Fundus photo — 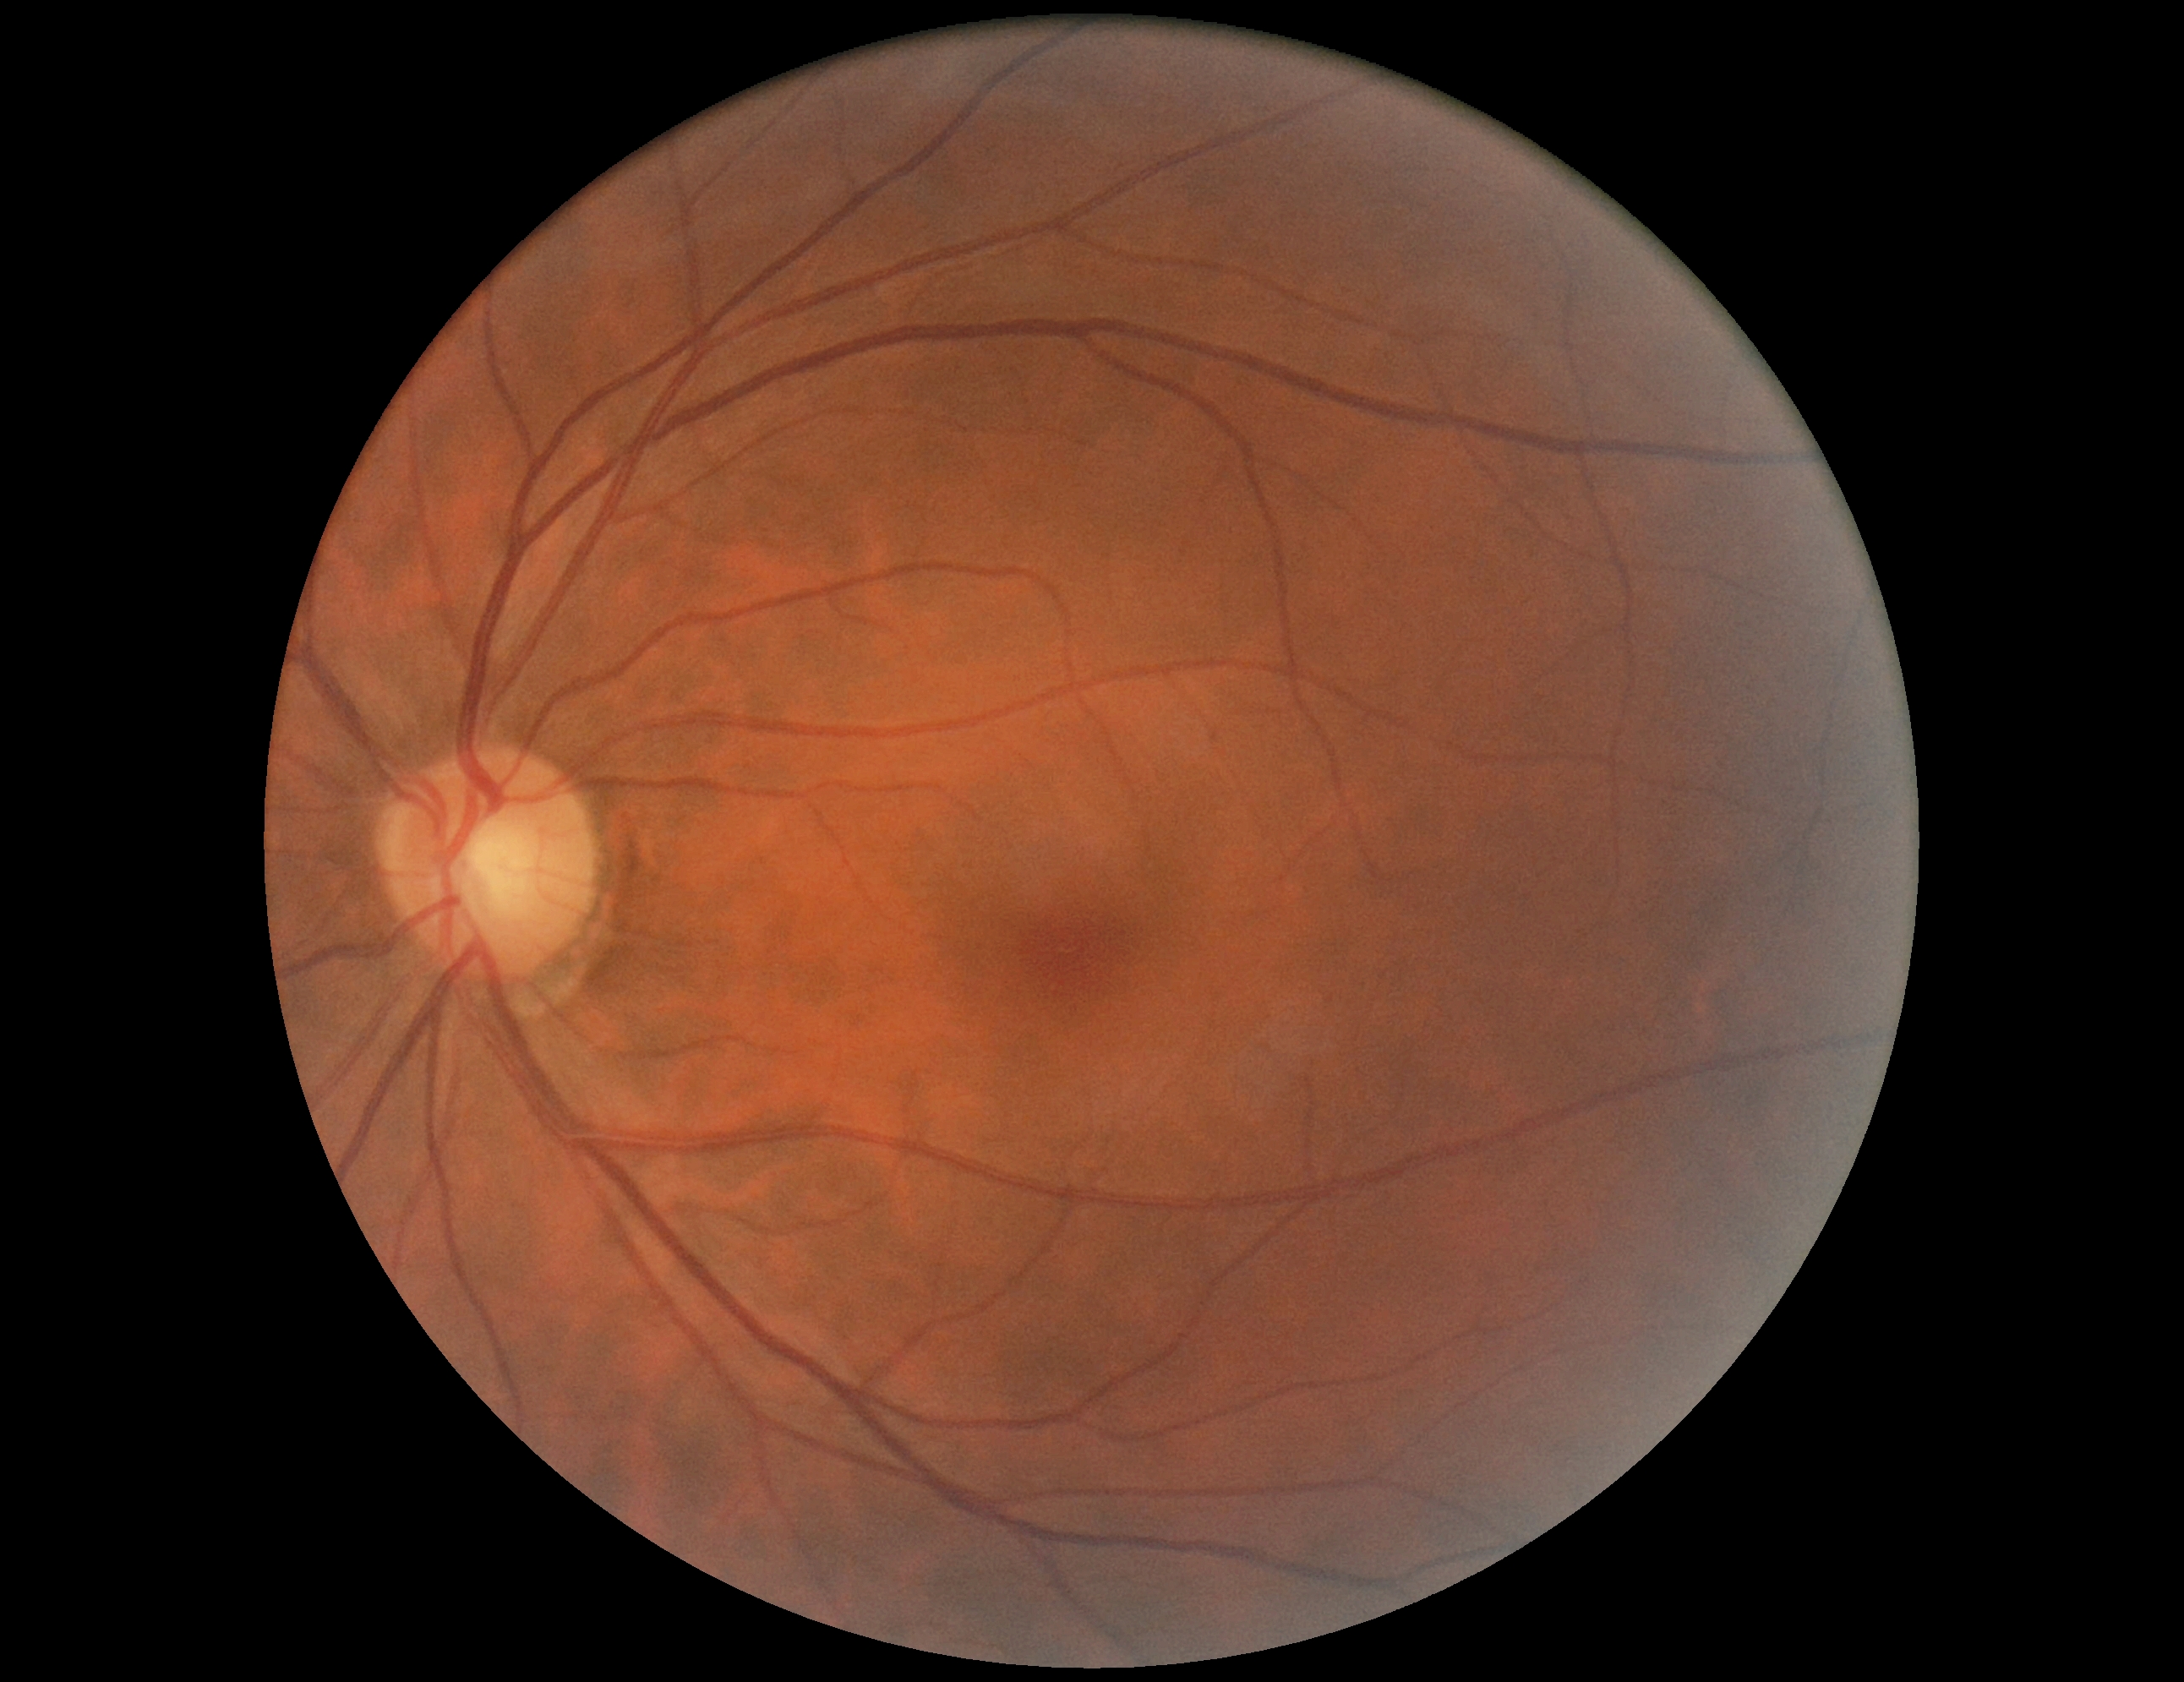

Retinopathy grade: 0 (no apparent retinopathy).